1932 x 1932 pixels.
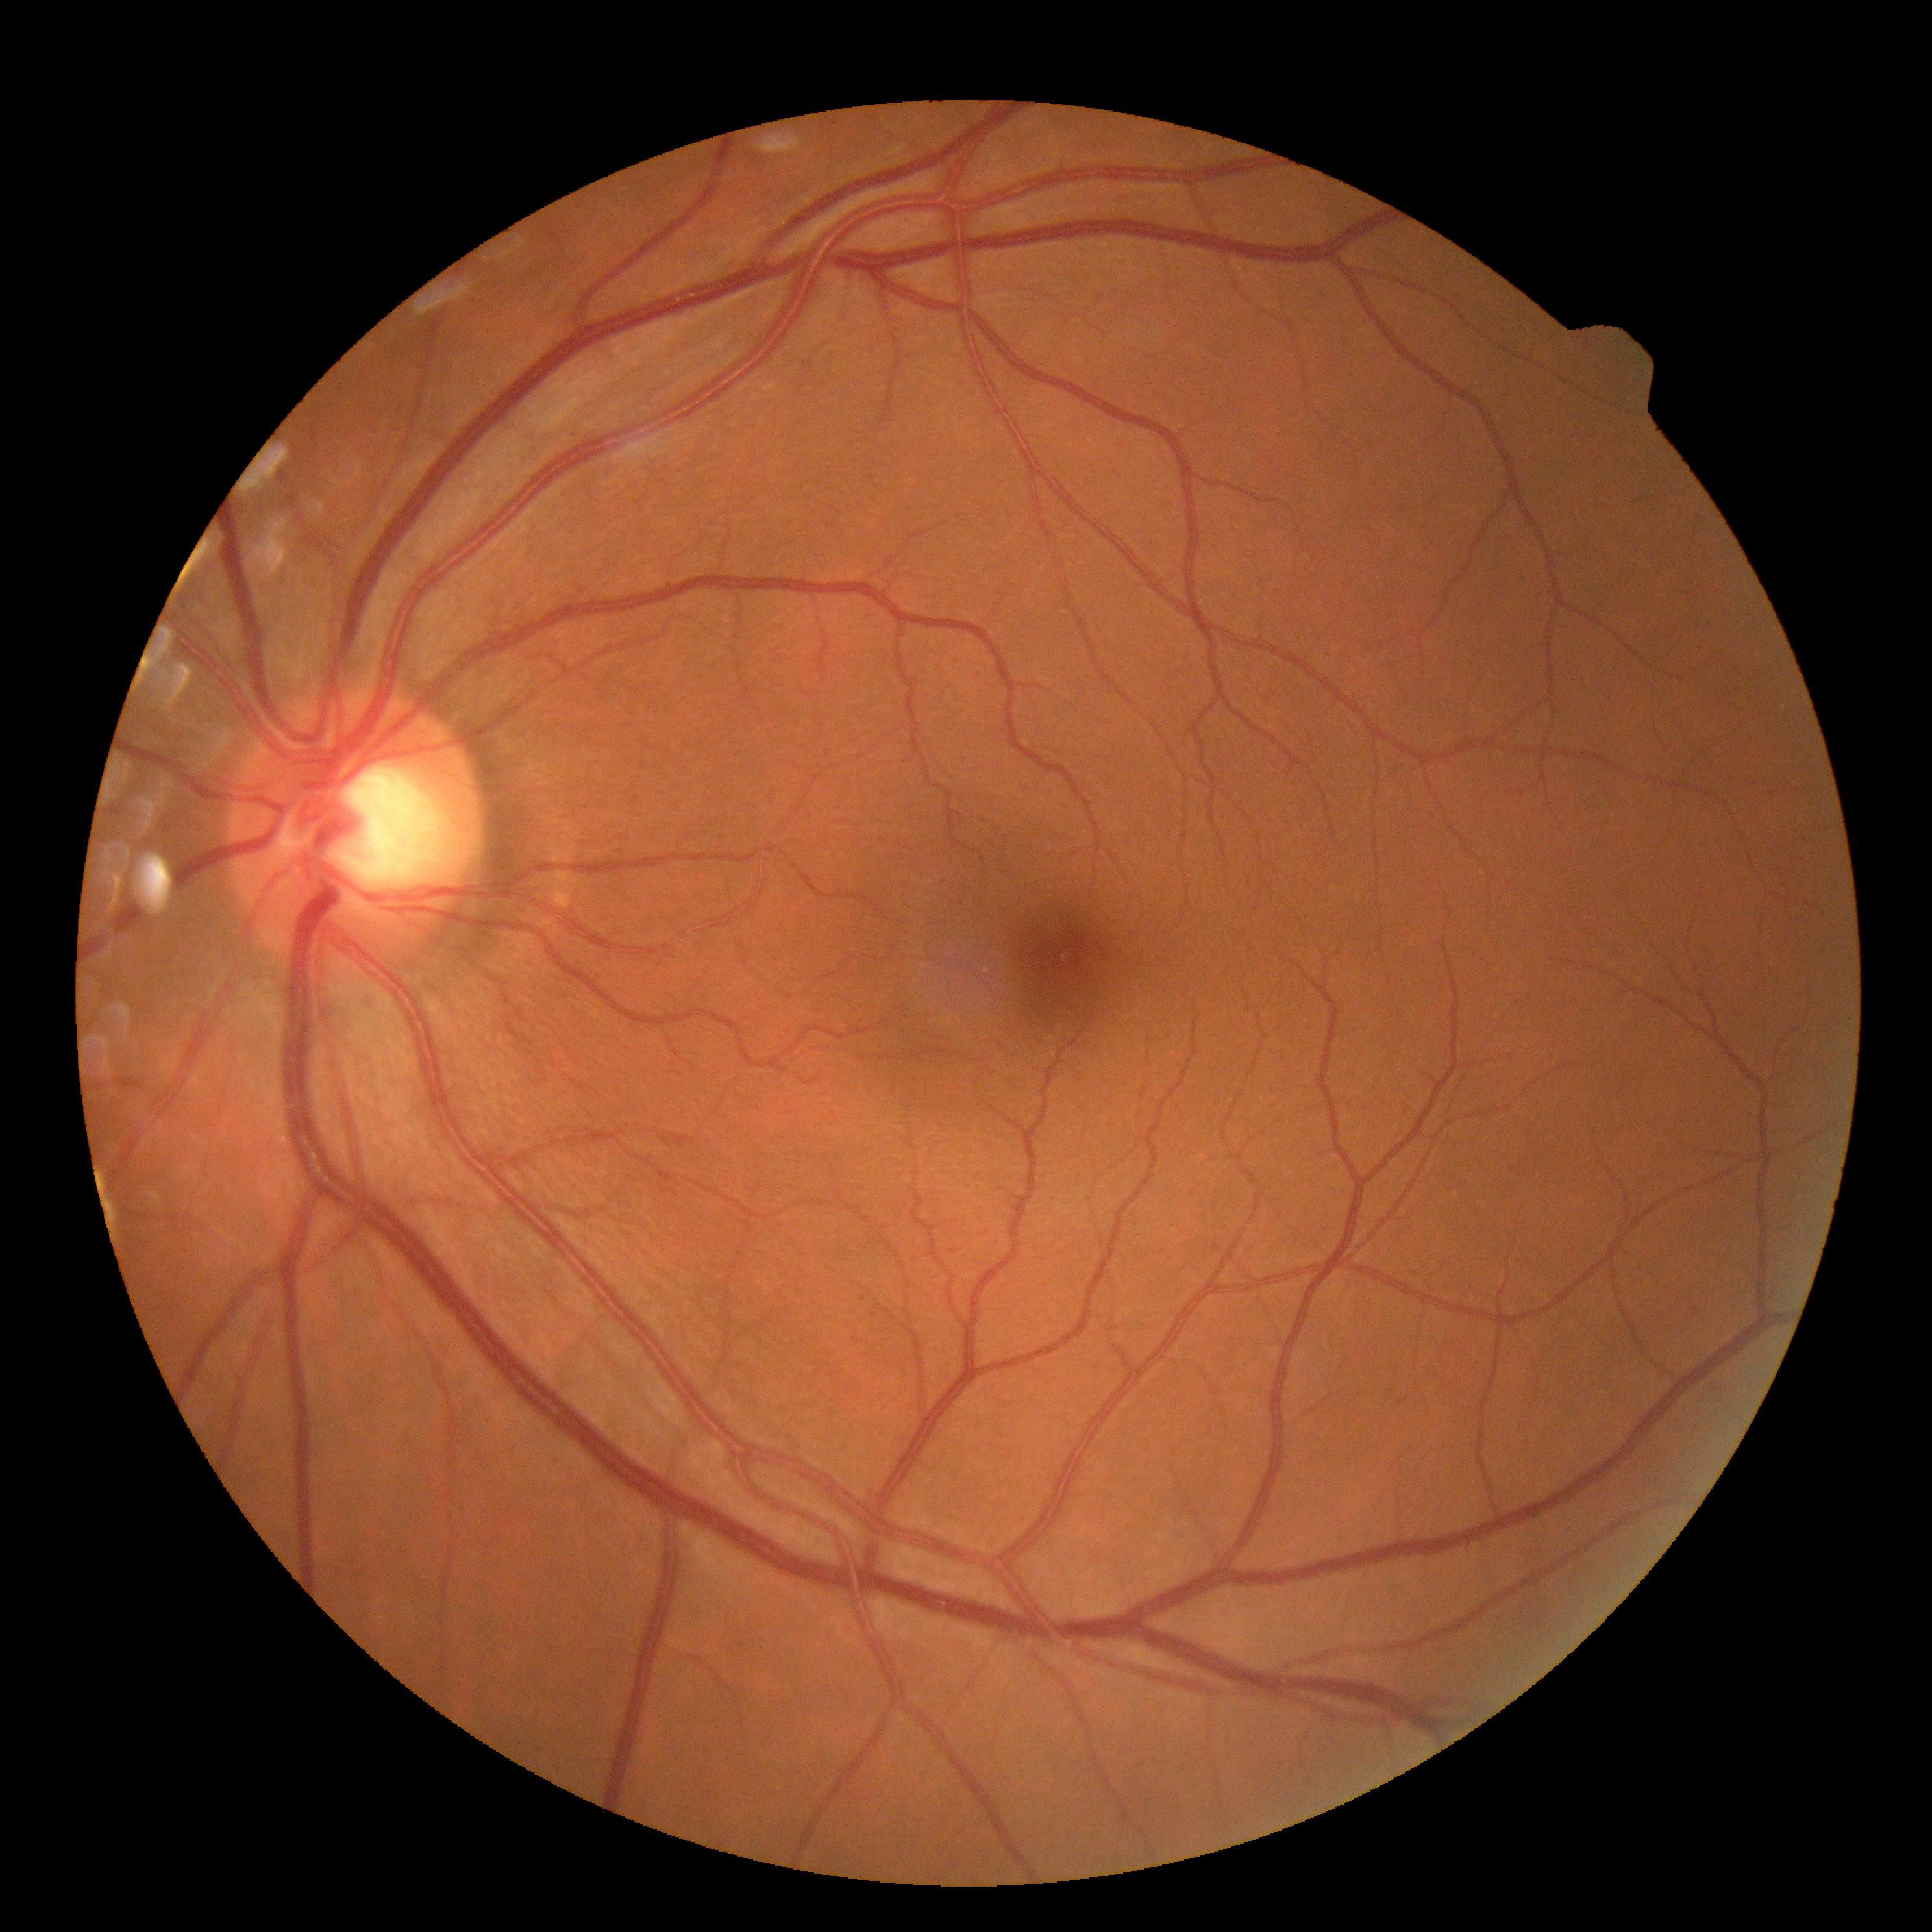

DR: no apparent diabetic retinopathy (grade 0).